CFP.
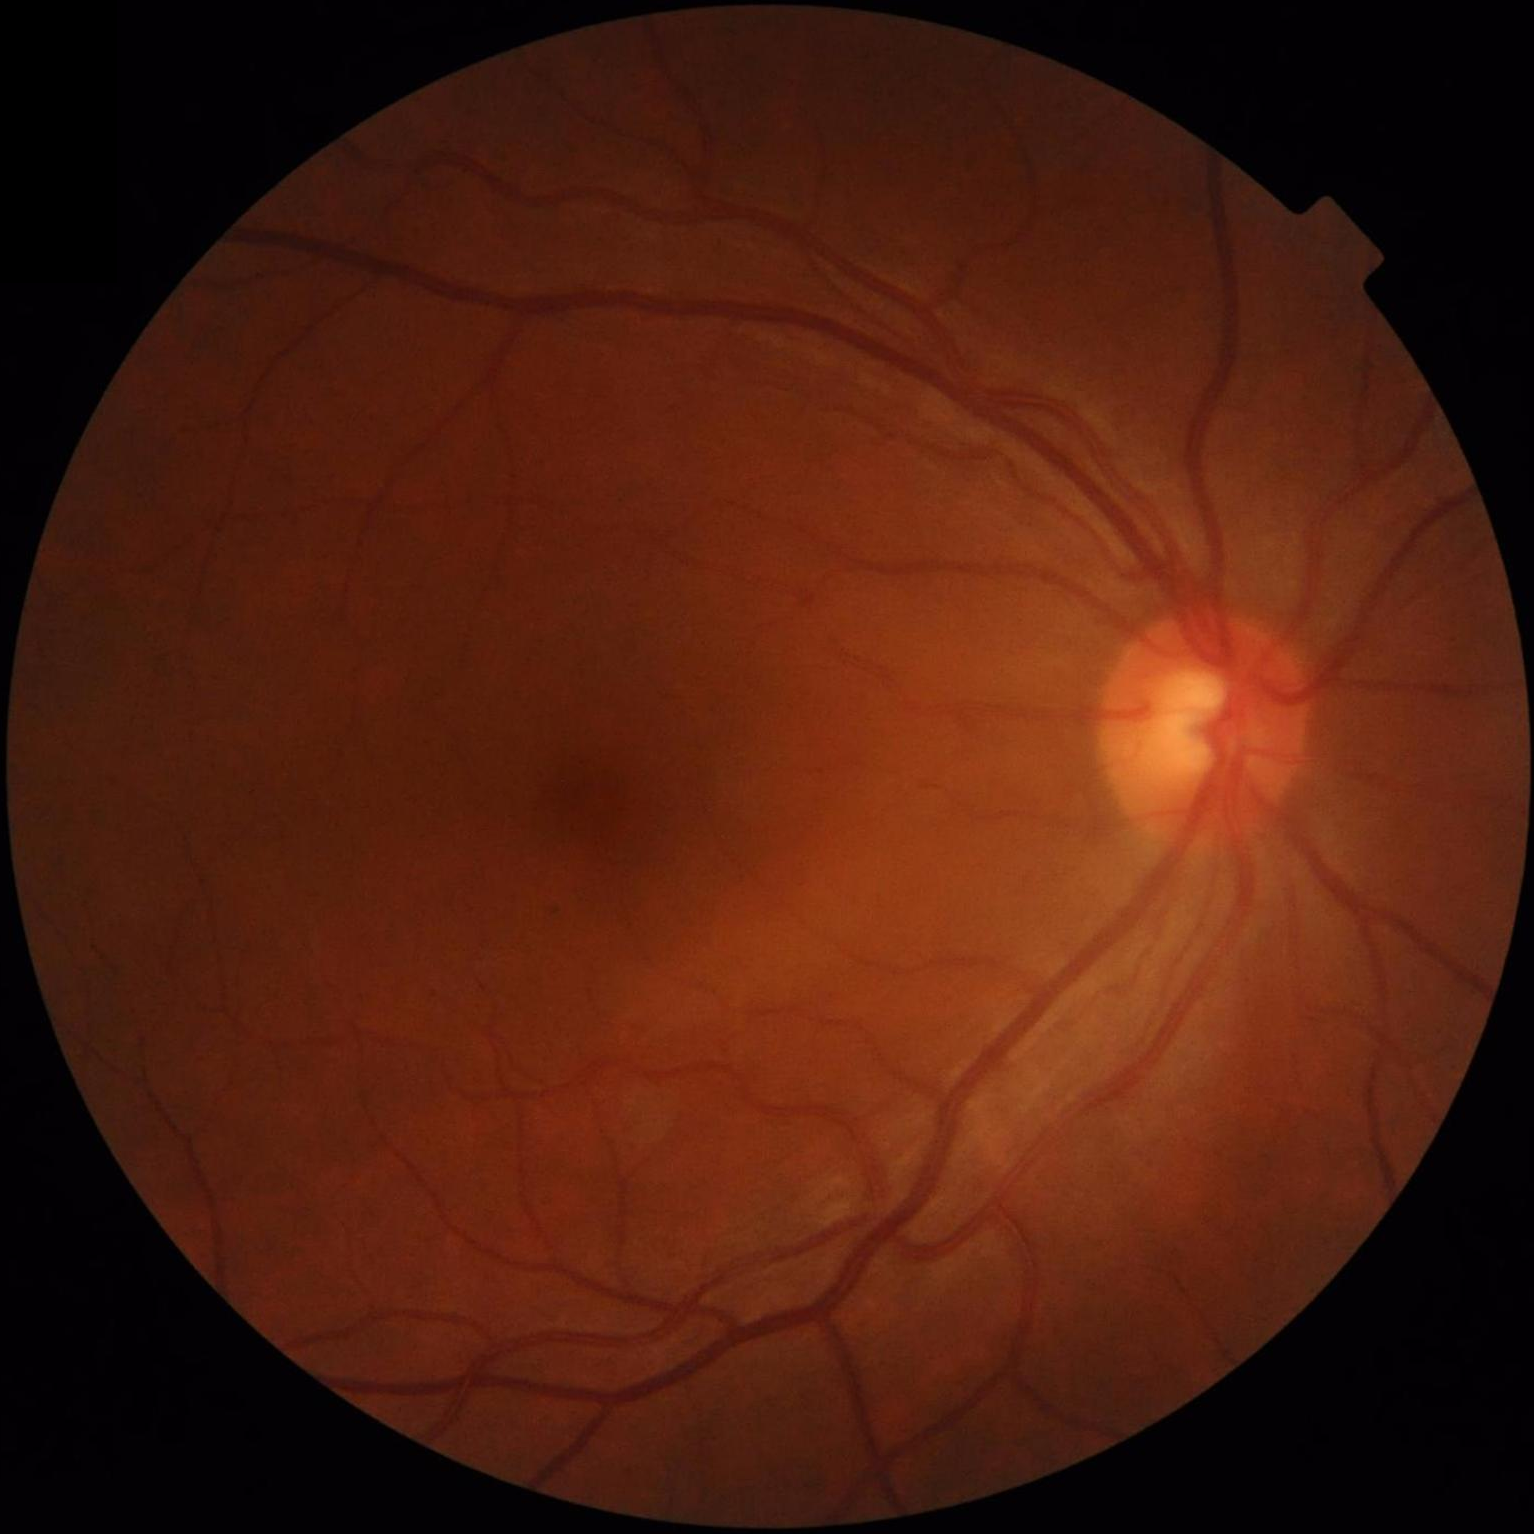 Quality assessment: overall: acceptable; illumination: satisfactory; clarity: in focus; contrast: adequate.